Pediatric wide-field fundus photograph. Captured with the Clarity RetCam 3 (130° field of view) — 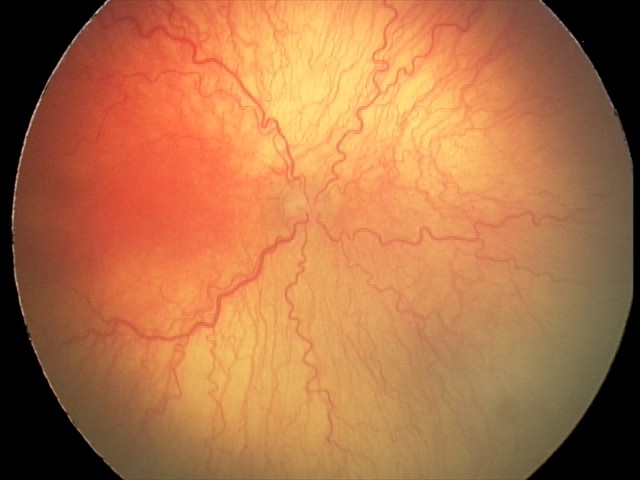

Plus disease was diagnosed.
Diagnosis from this screening exam: aggressive retinopathy of prematurity.